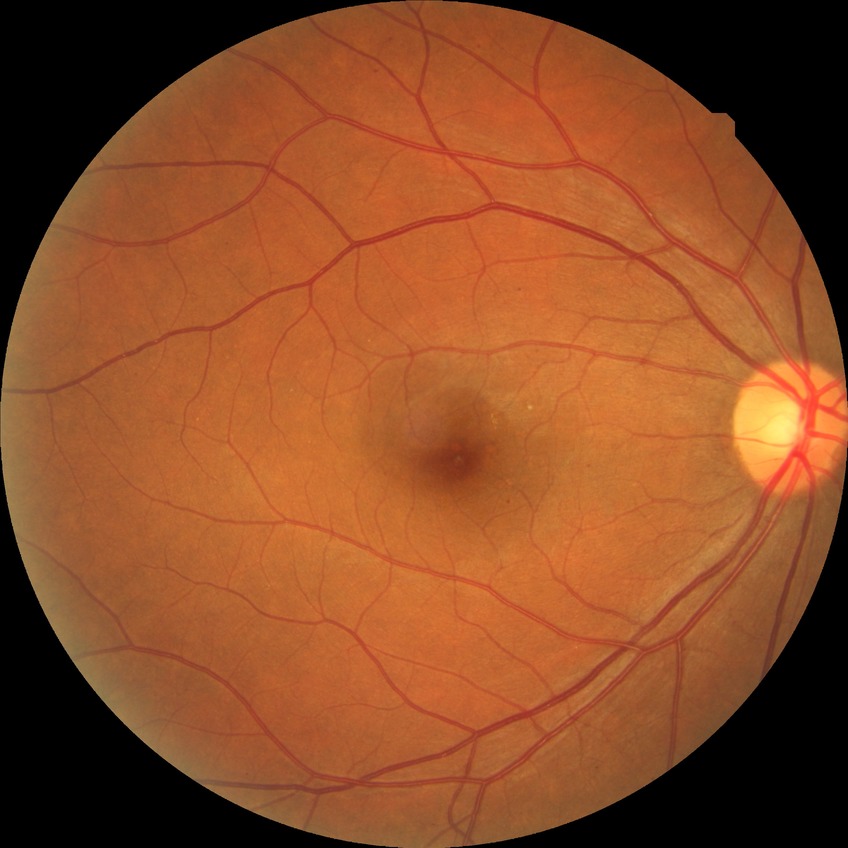

Diabetic retinopathy (DR): simple diabetic retinopathy (SDR).